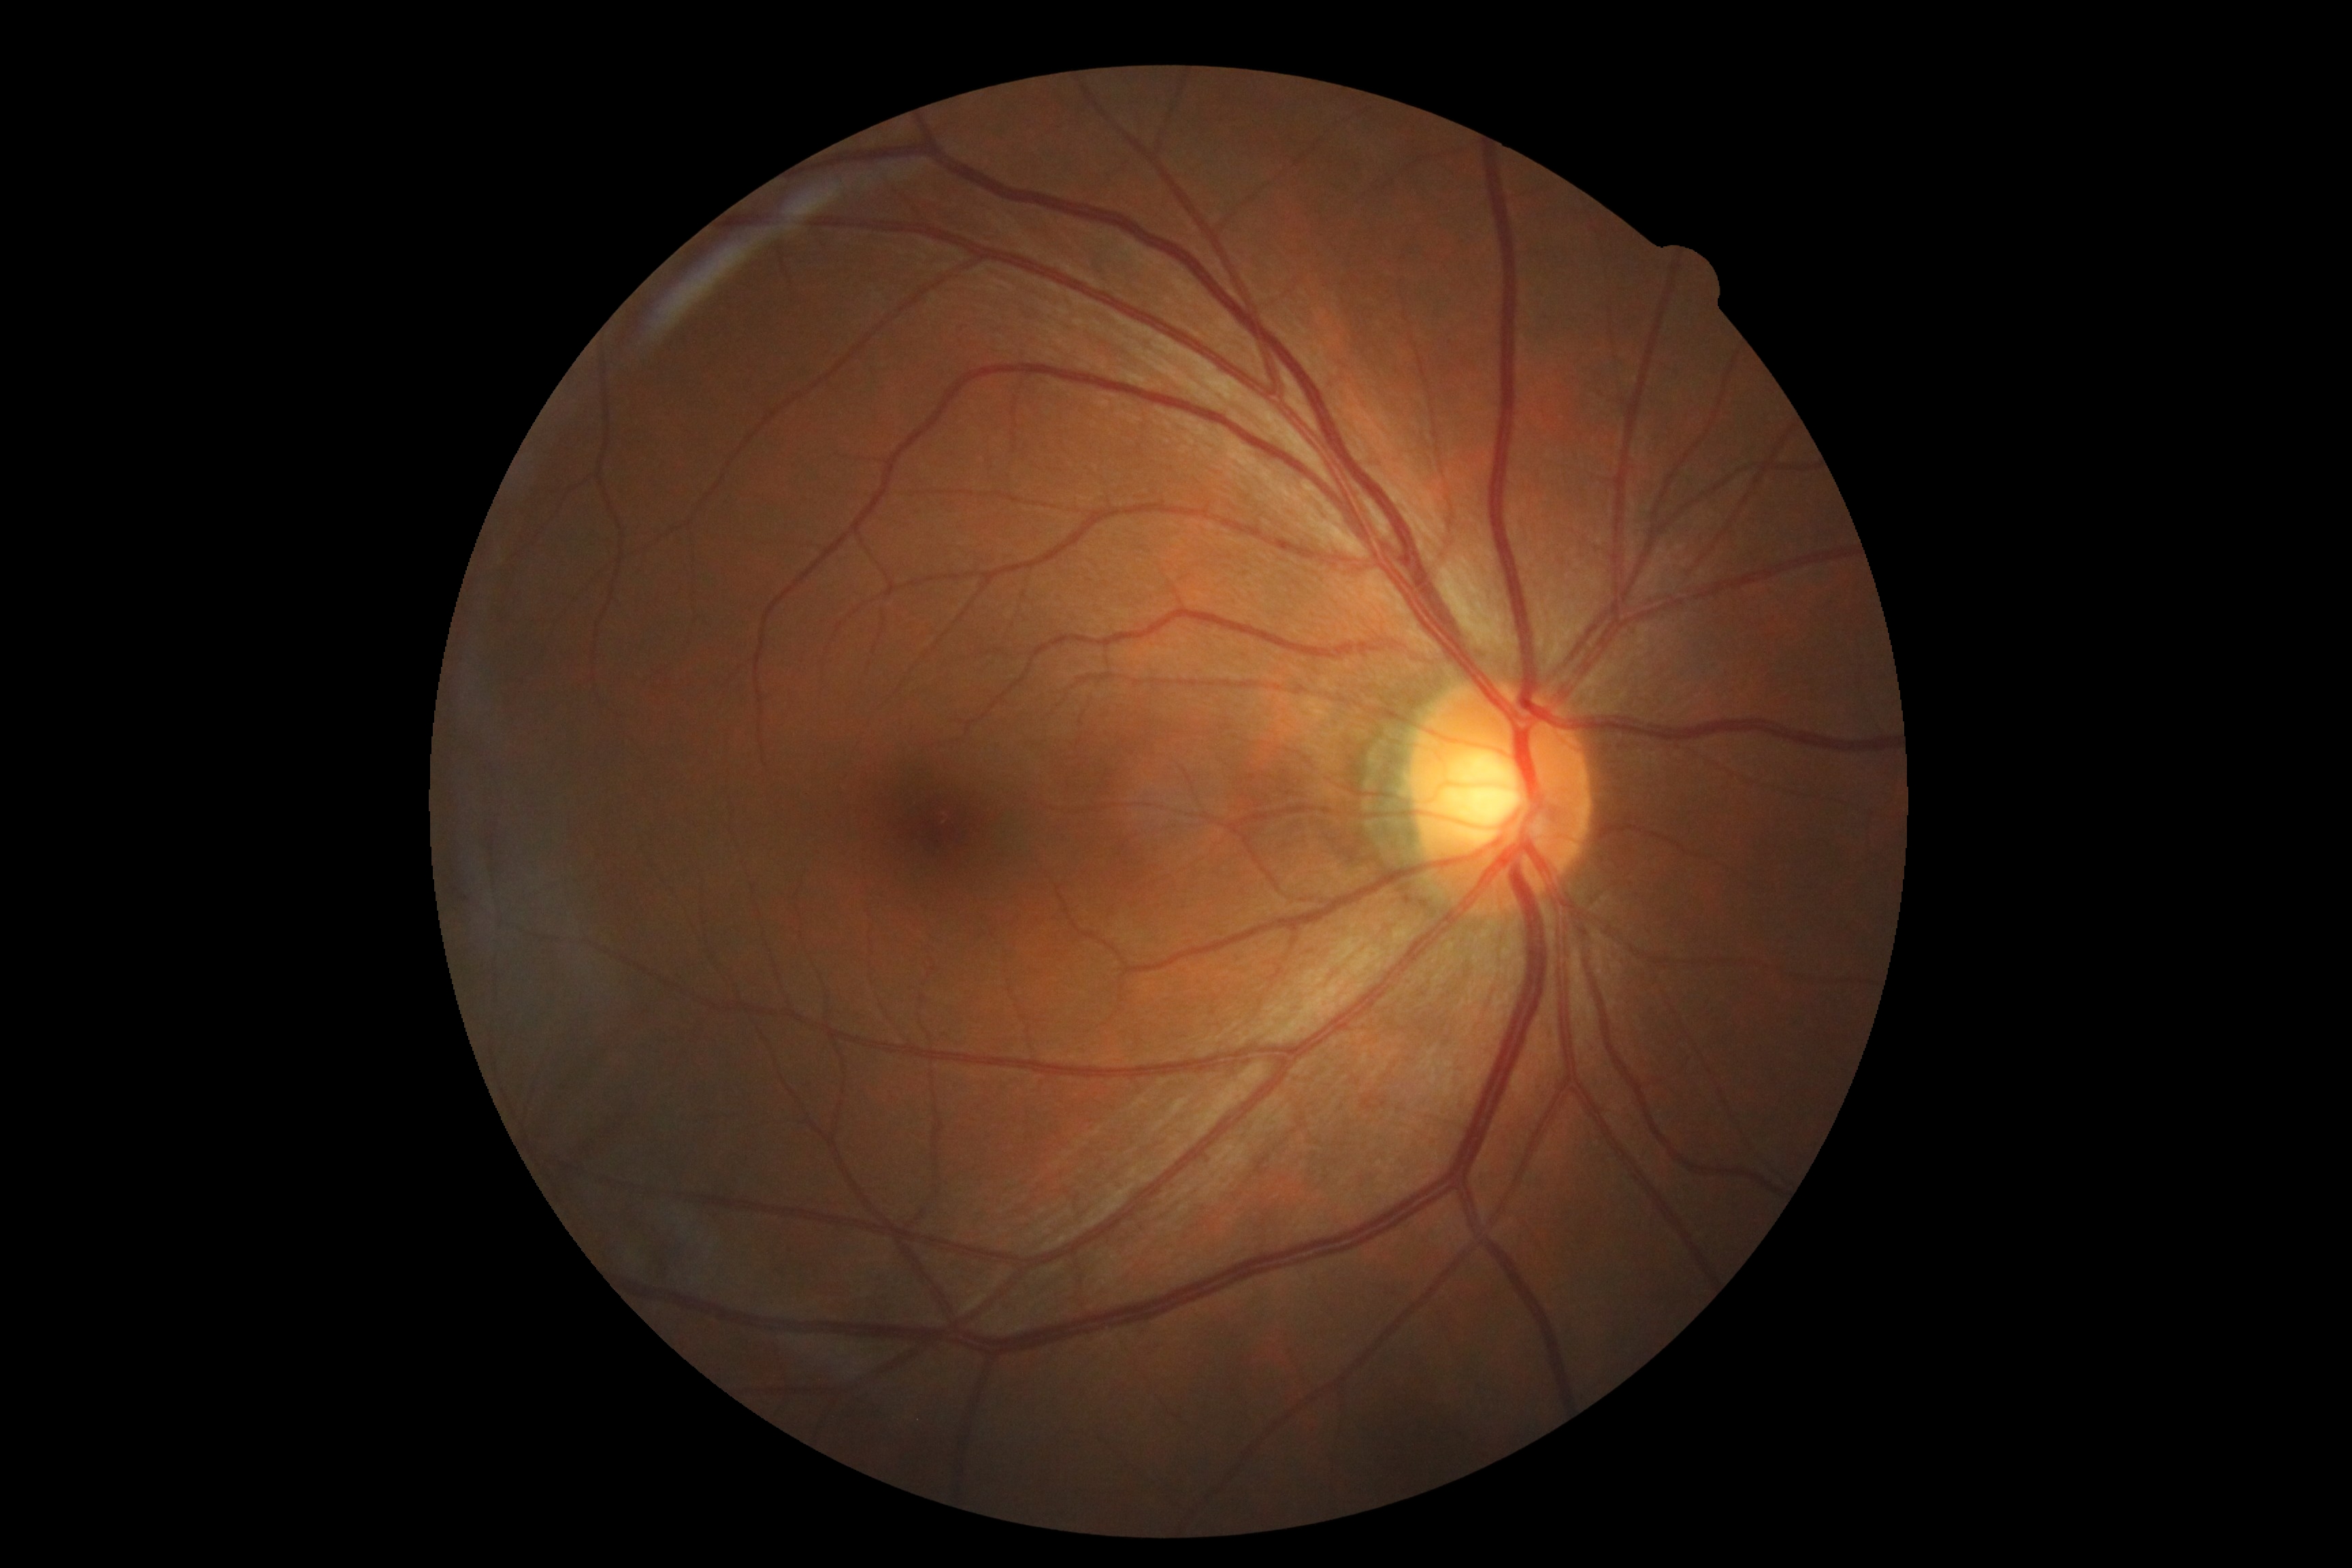   dr_grade: no apparent diabetic retinopathy (0)
  dr_impression: no DR findings